240x240:
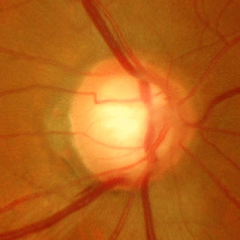

Q: Does this eye have glaucoma?
A: Yes — severe glaucomatous damage. Defined as near-total cupping of the optic nerve head, with or without severe visual field loss within the central 10 degrees of fixation.